2352x1568
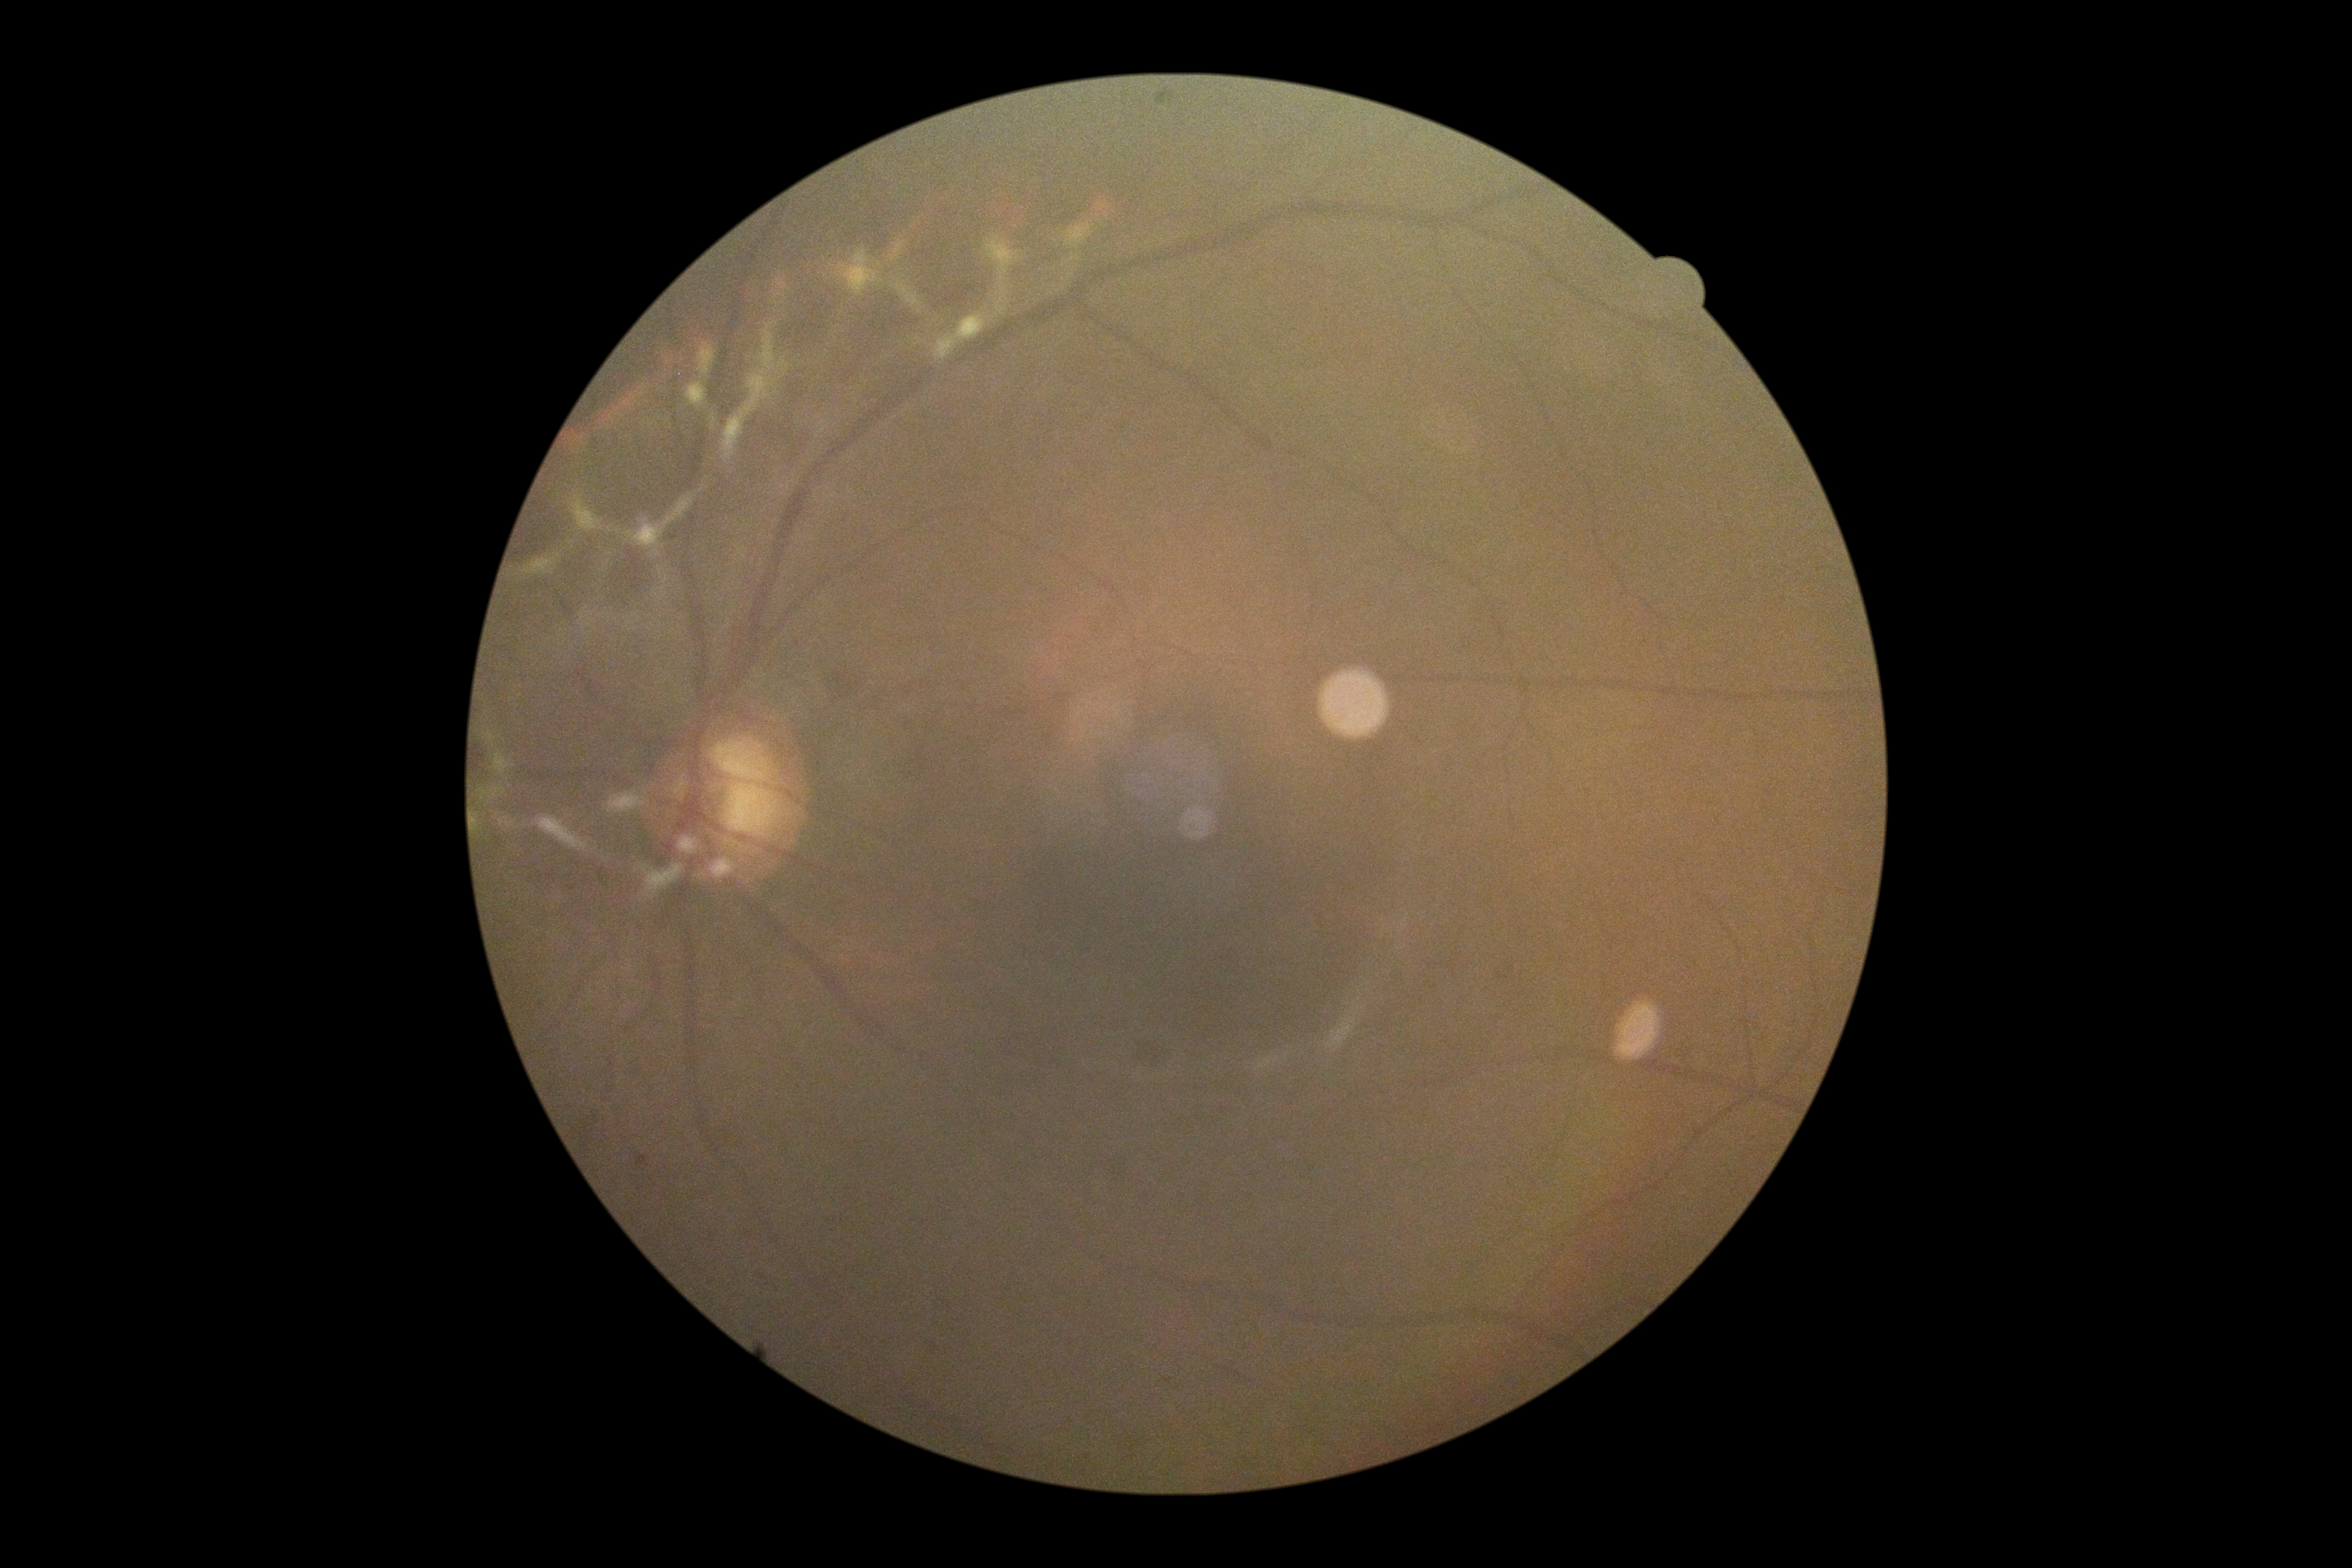
No DR findings. Retinopathy grade is no apparent diabetic retinopathy (0) — no visible signs of diabetic retinopathy.